Axial length: 22.53 mm · woman · intraocular pressure (IOP) 13 mmHg (non-contact tonometry) · pachymetry 495 µm:
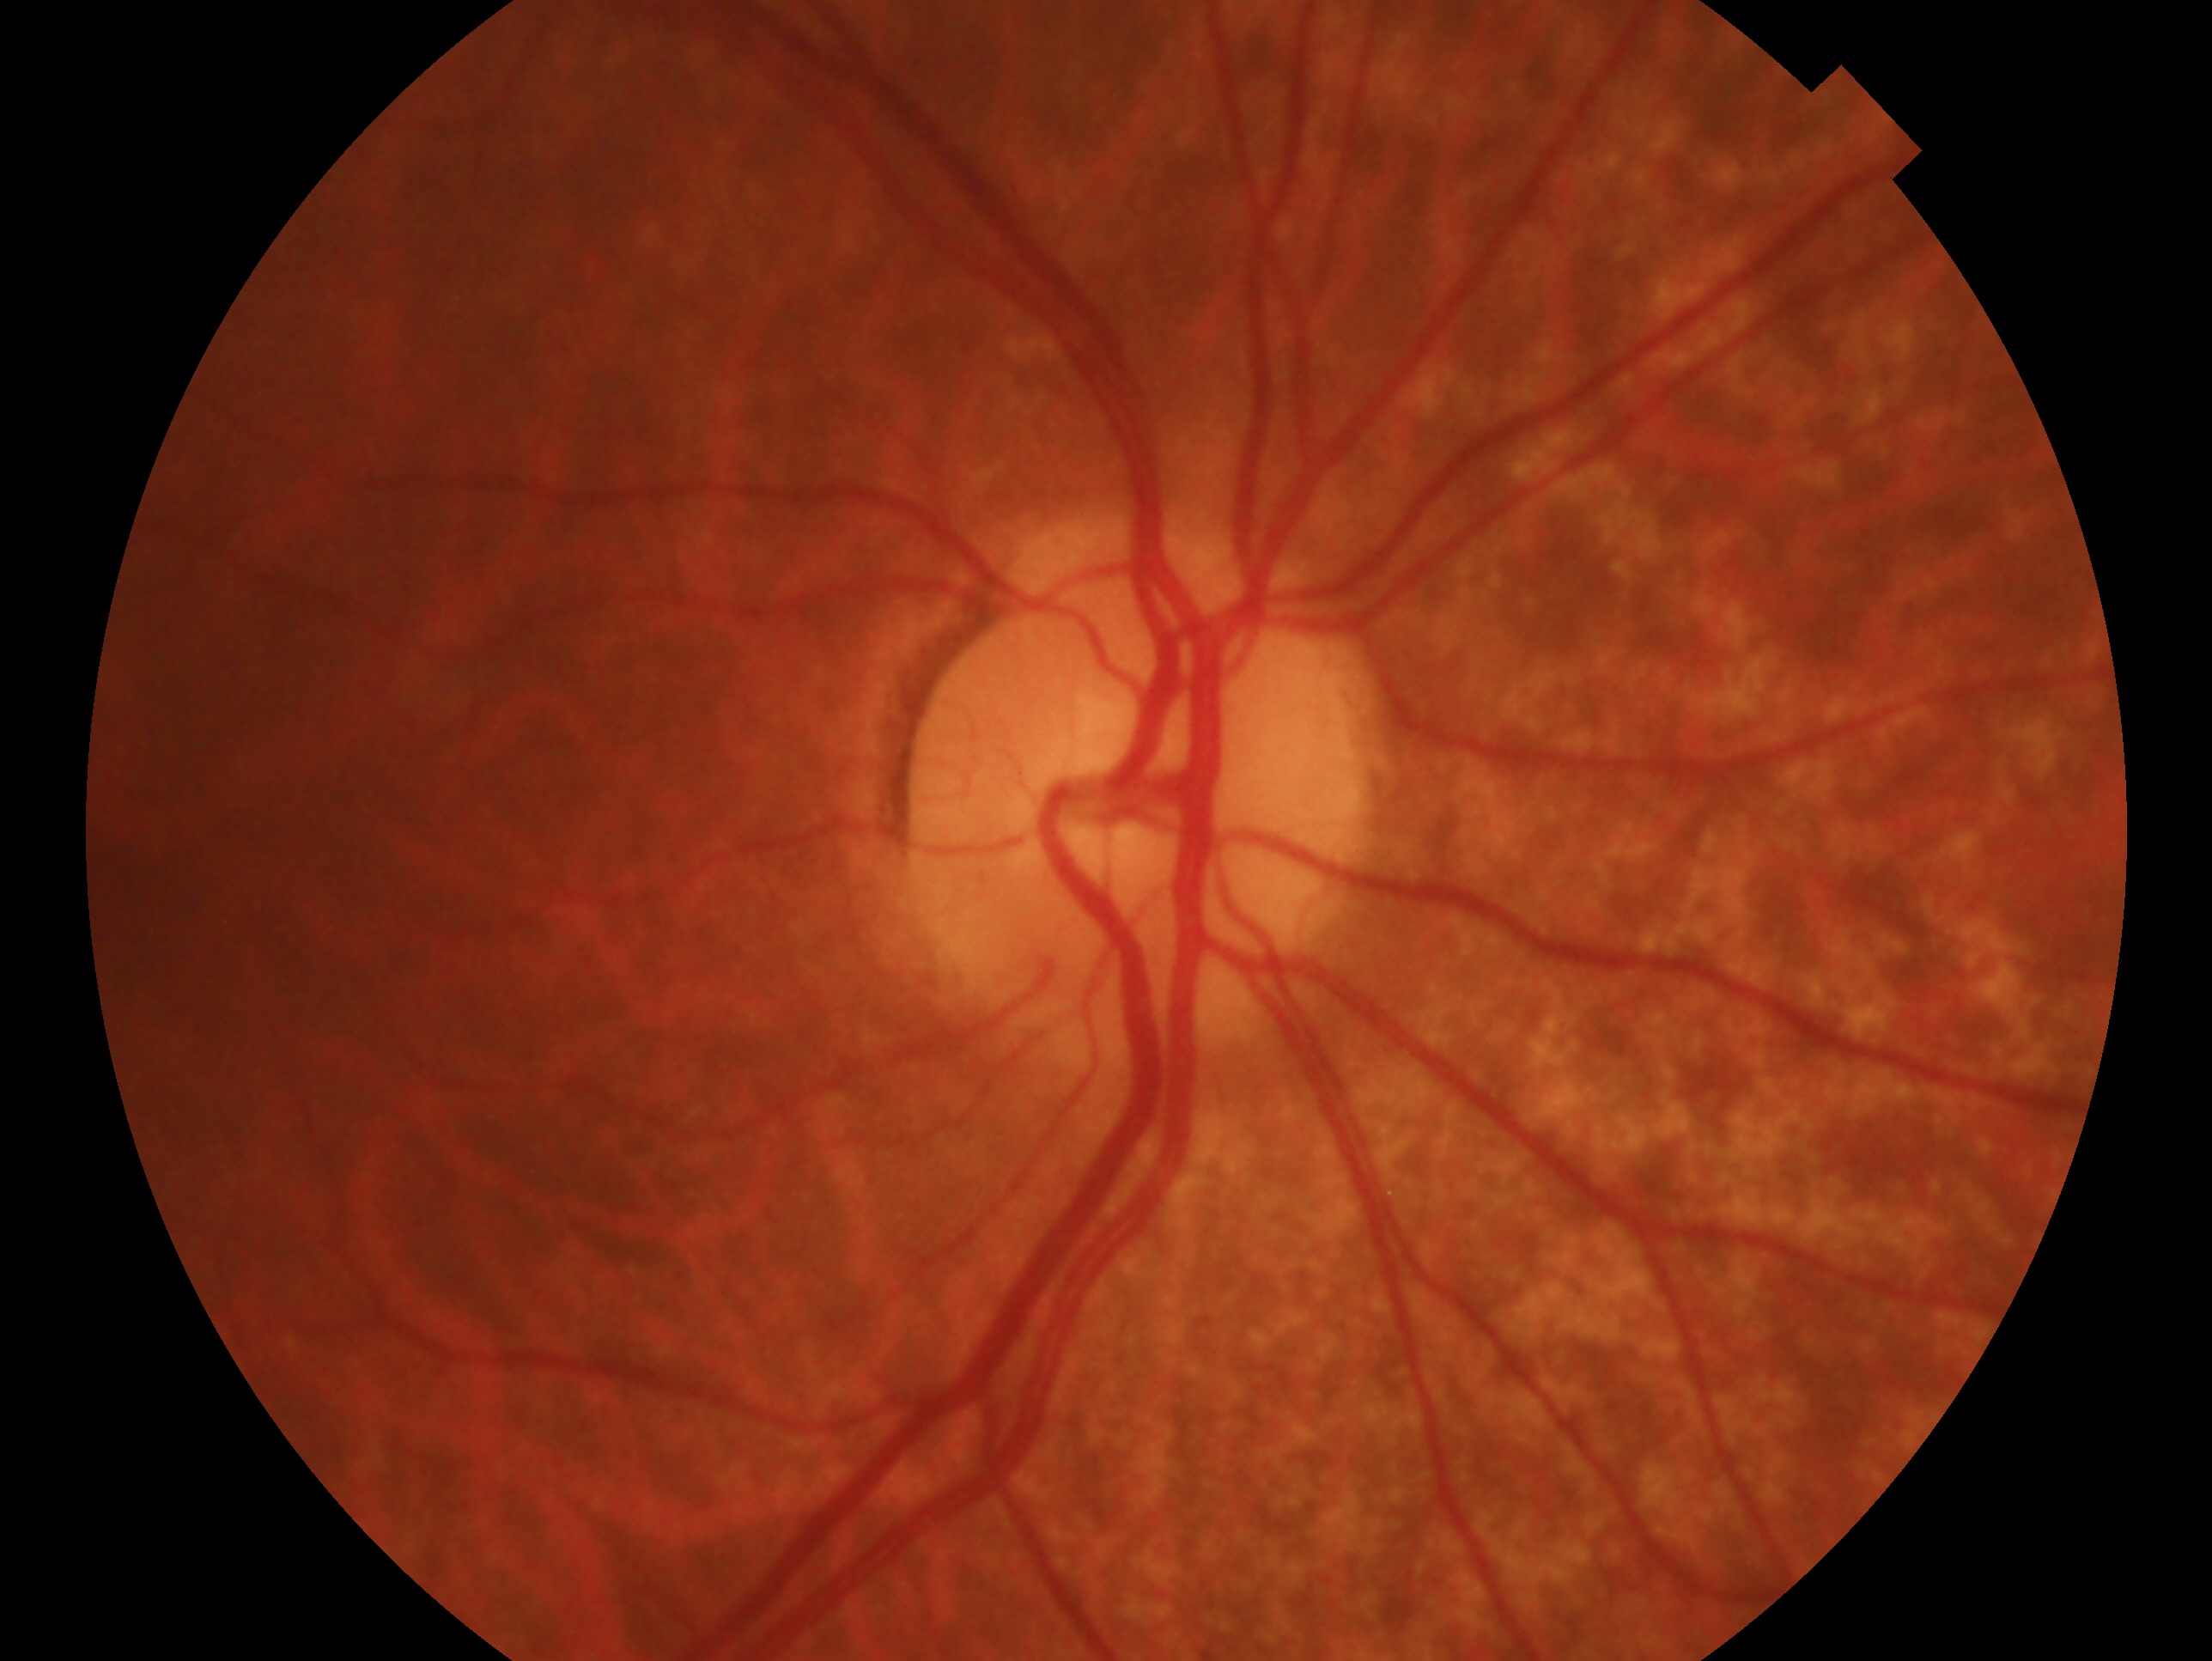
Q: Which eye is imaged?
A: OD
Q: What is the glaucoma diagnosis?
A: no evidence of glaucoma